Woman patient. Central corneal thickness 555 µm. Axial length 22.66 mm. Acquired with a Topcon TRC-NW400. 30-degree field of view. Autorefraction: -0.5 -0.25 × 148°:
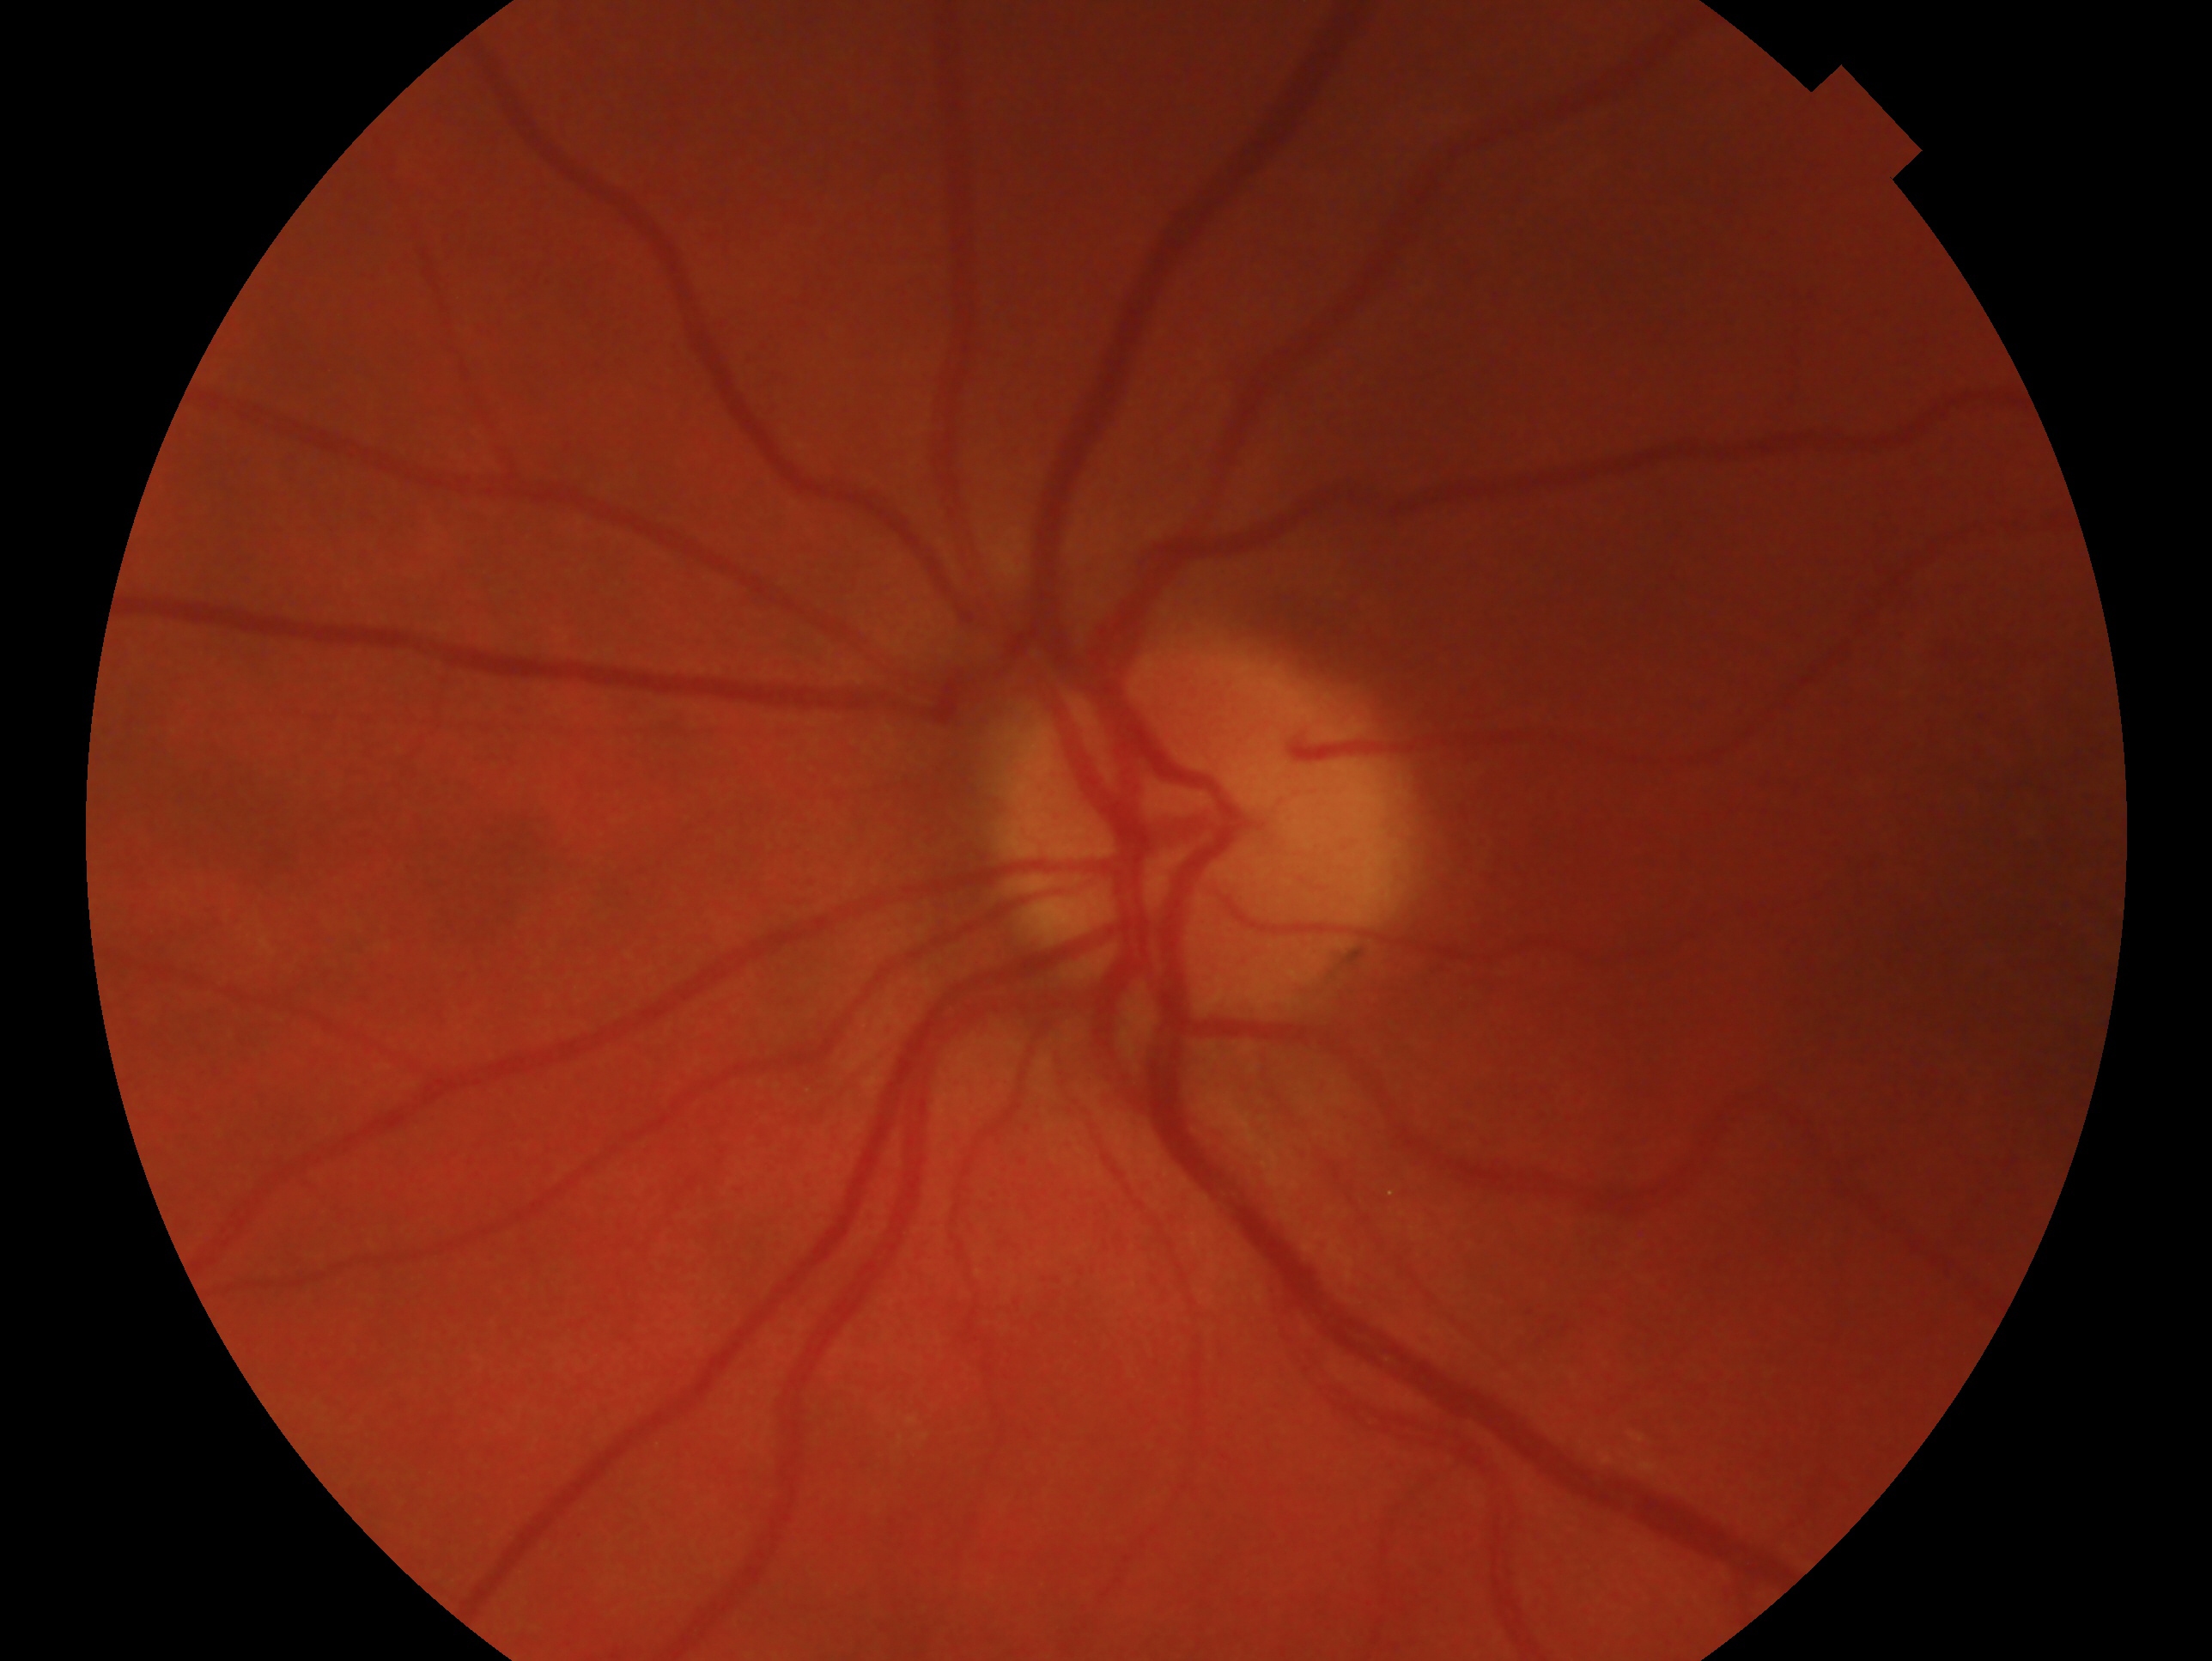

Clinical classification — no signs of glaucoma.
The image shows the left eye.